2352 x 1568 pixels:
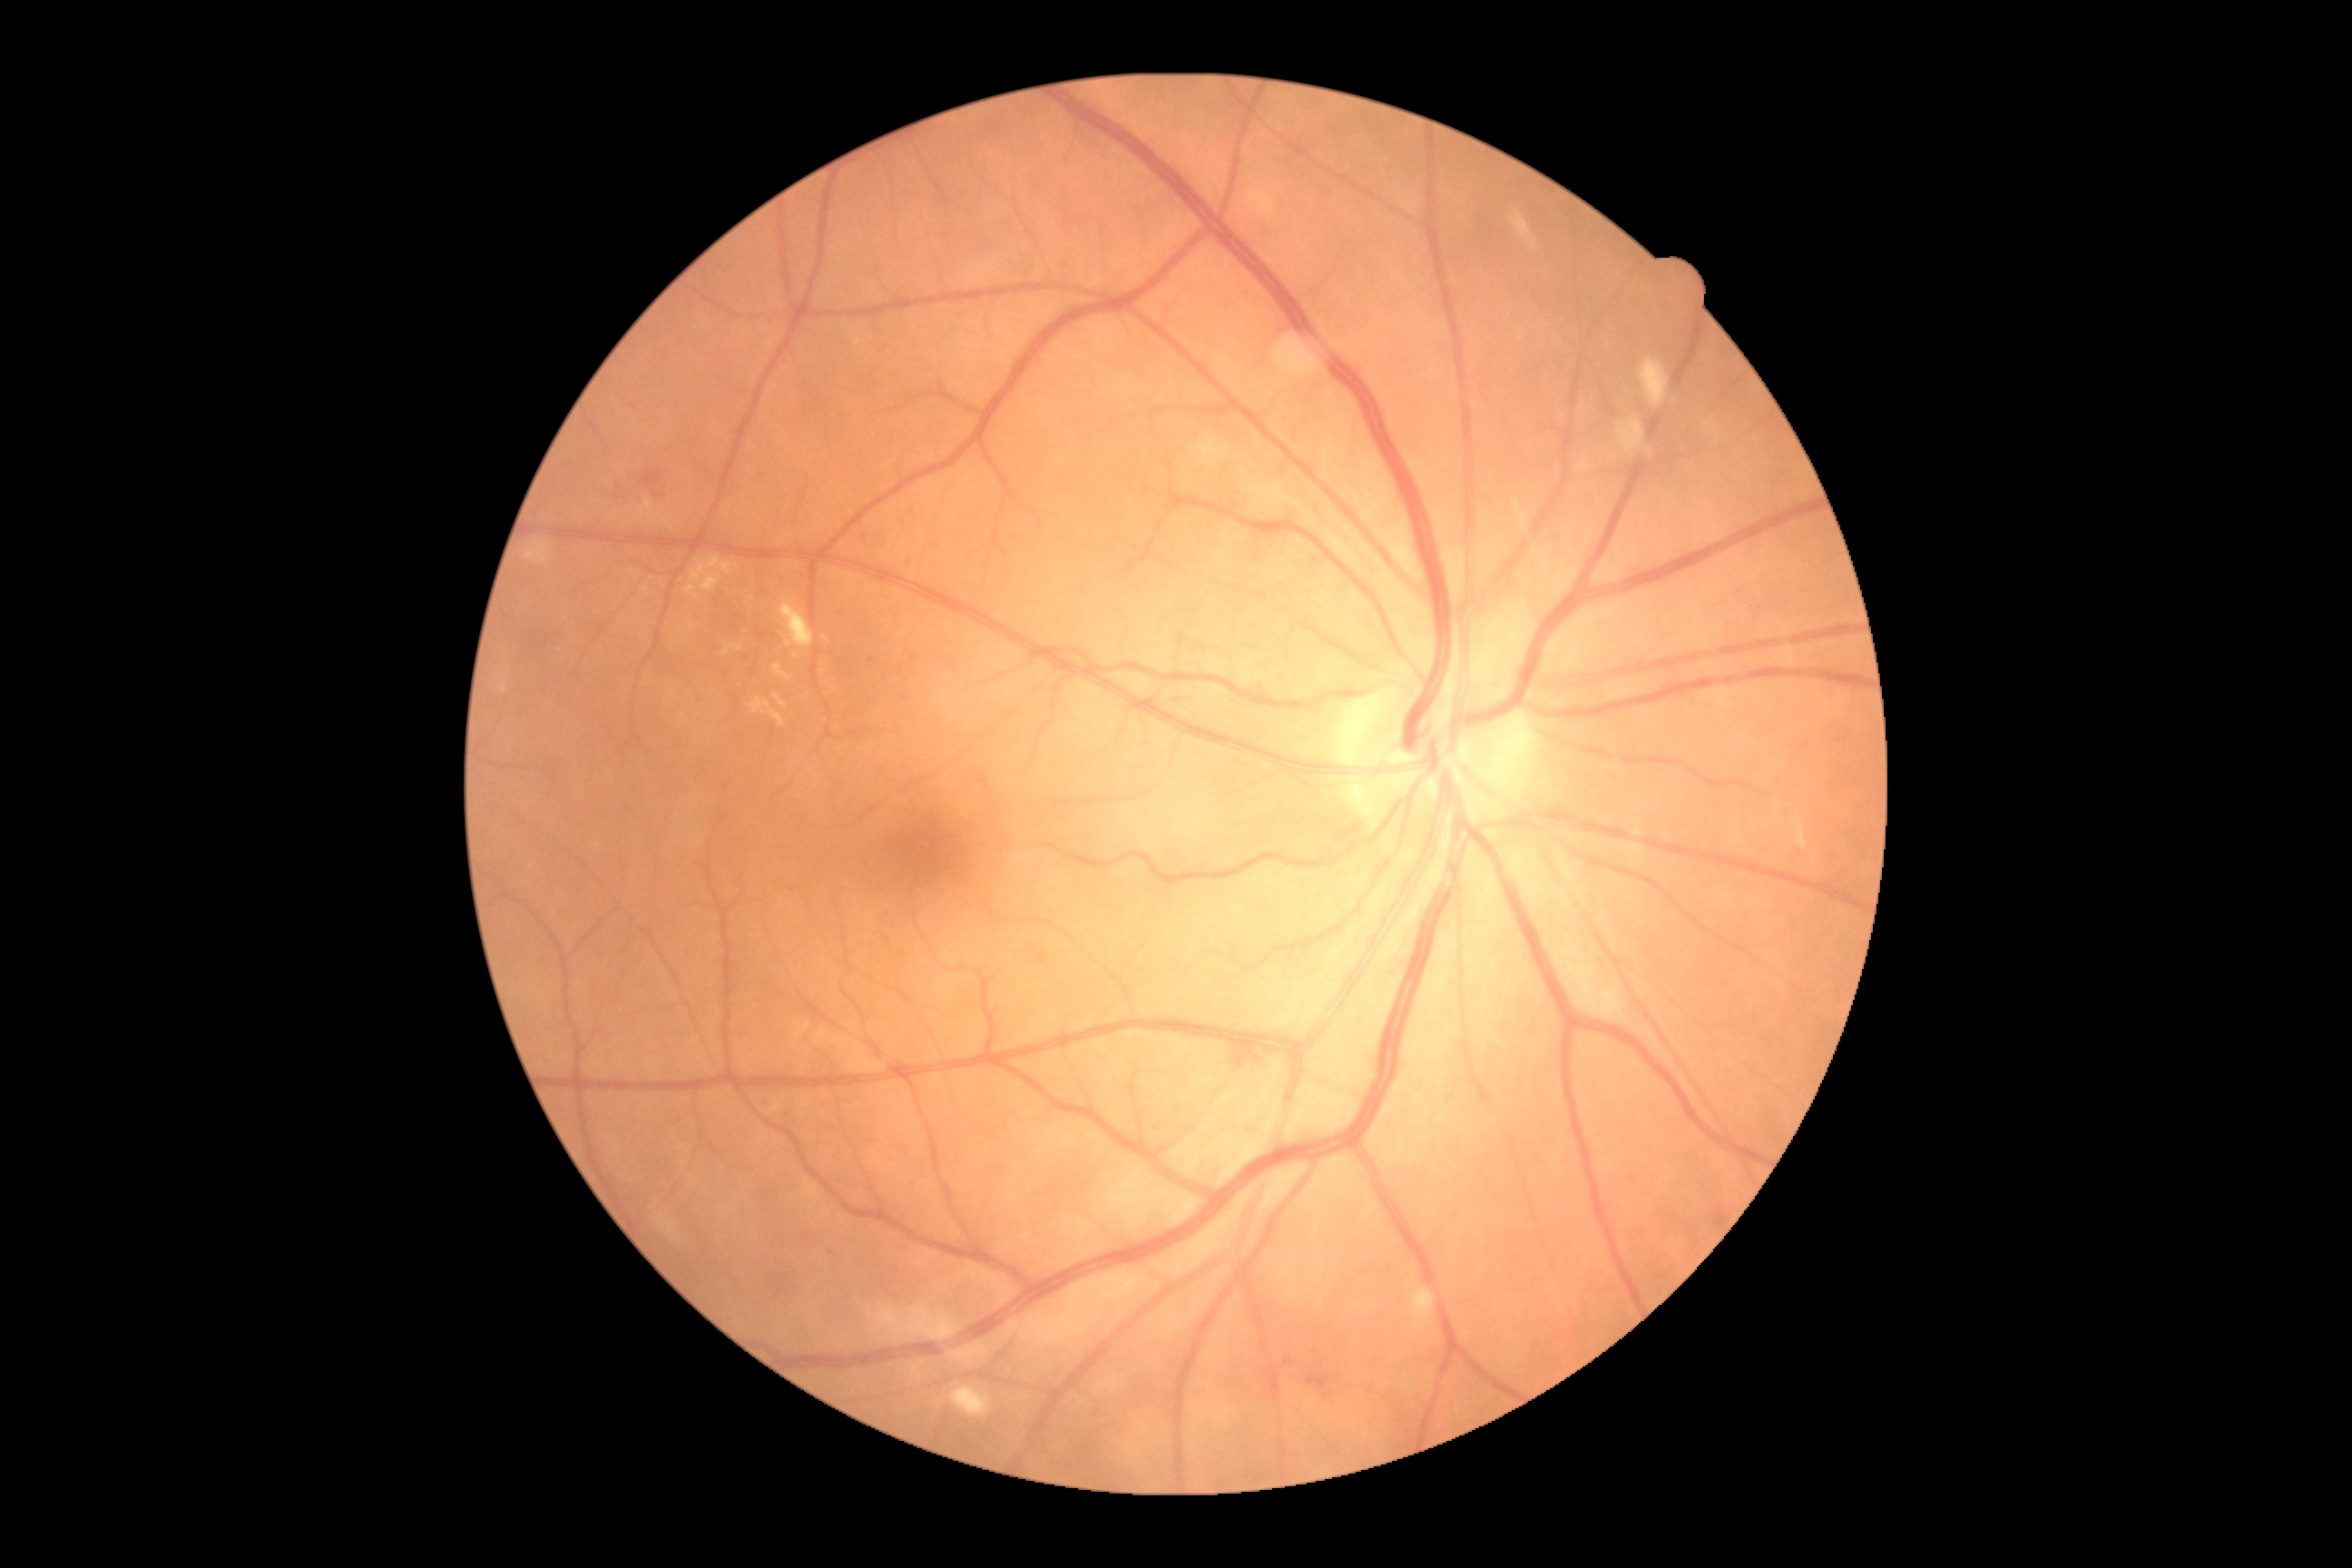
Annotations:
* diabetic retinopathy severity: grade 2 (moderate NPDR)